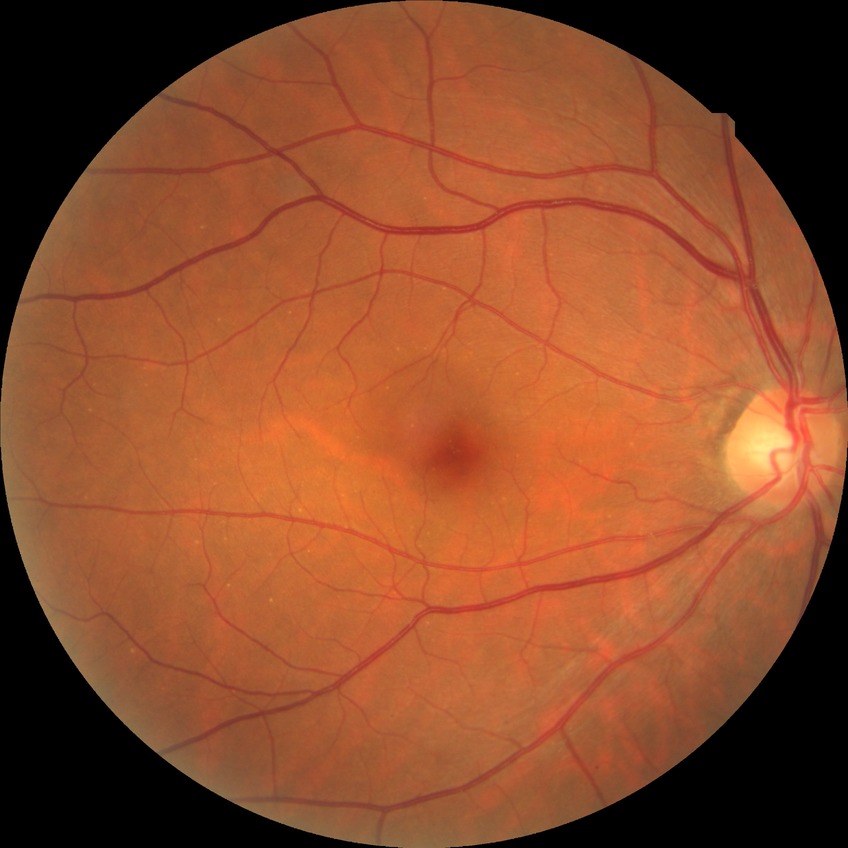
Diabetic retinopathy (DR): no diabetic retinopathy (NDR).